Pupil-dilated, 50-degree field of view, acquired with a Topcon TRC-50DX.
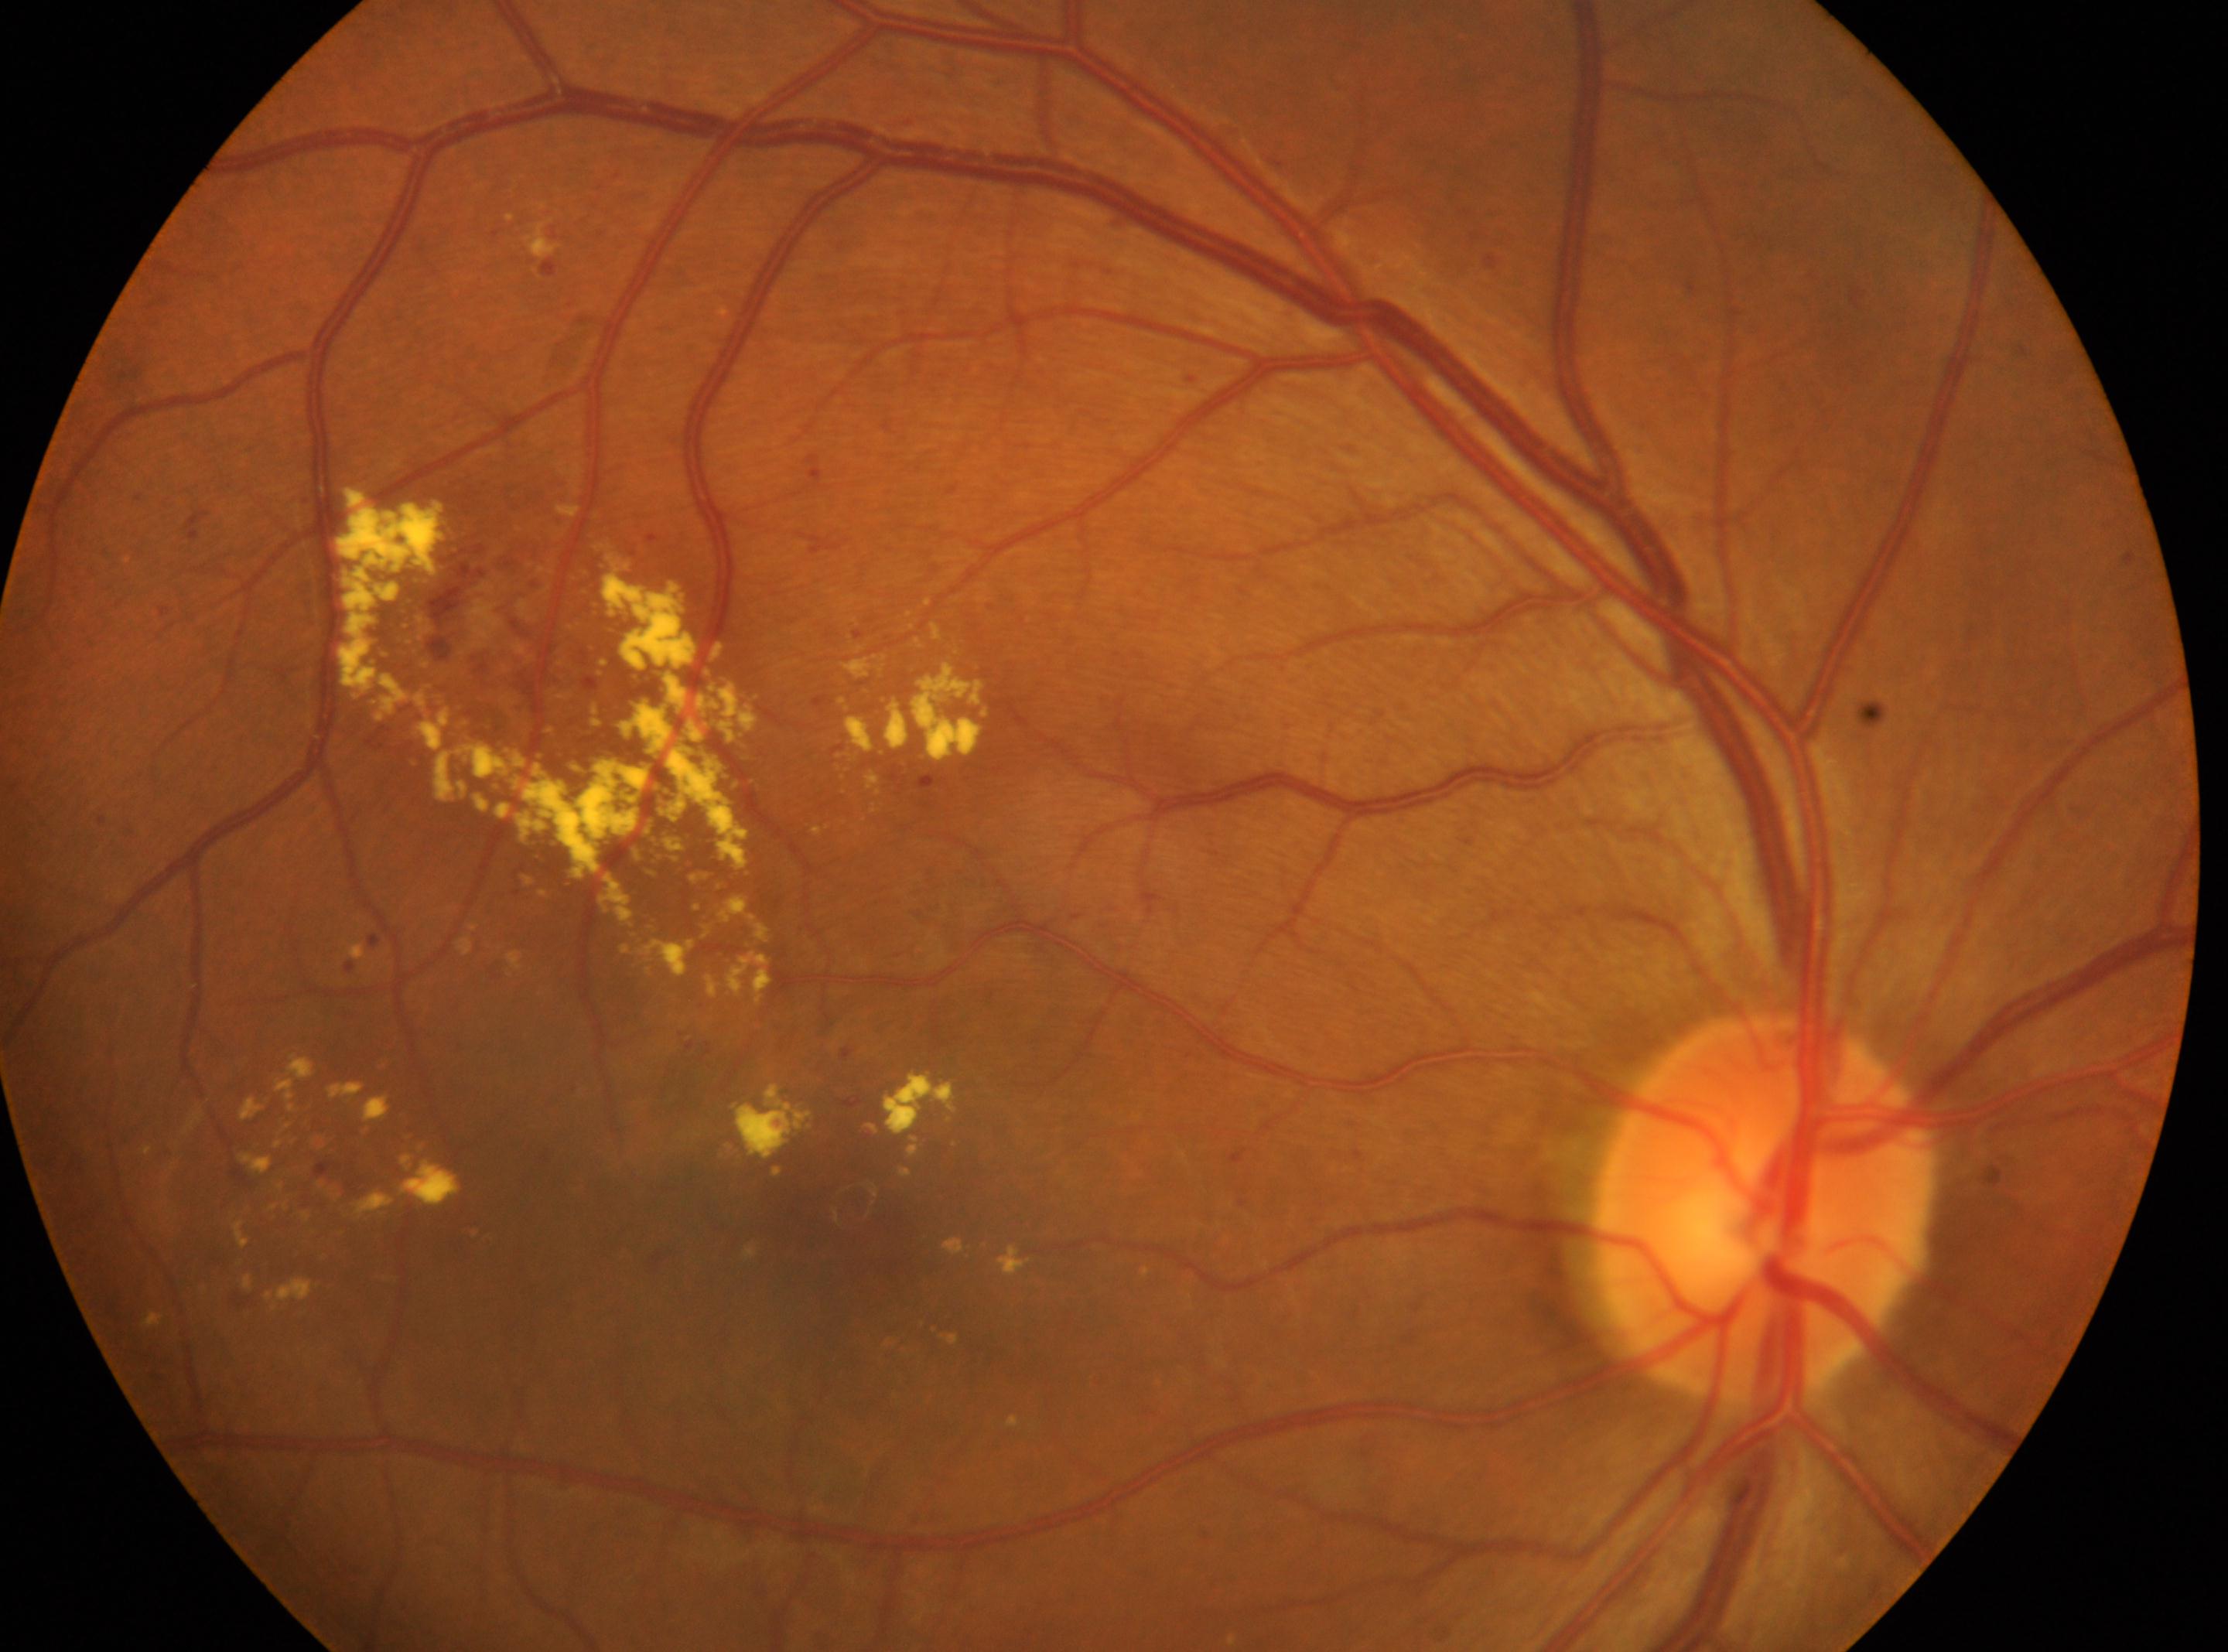

DR class: non-proliferative diabetic retinopathy, optic nerve head: (1762,1206), diabetic retinopathy (DR): grade 2 (moderate NPDR), eye: OD, macula center: (849,1251).